Clarity RetCam 3, 130° FOV. Infant wide-field fundus photograph — 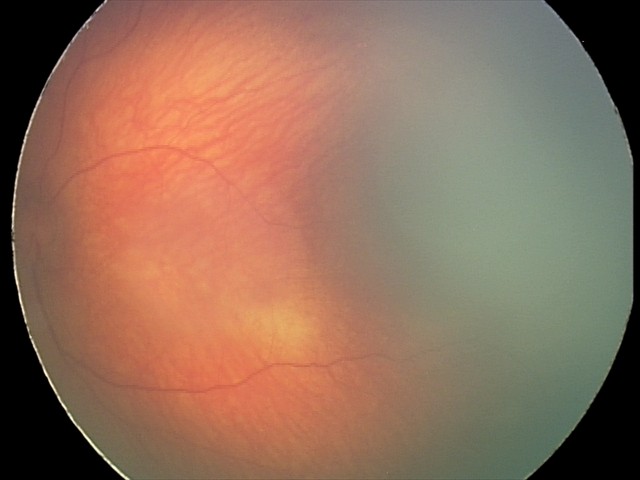
Examination with physiological retinal findings.